848 by 848 pixels
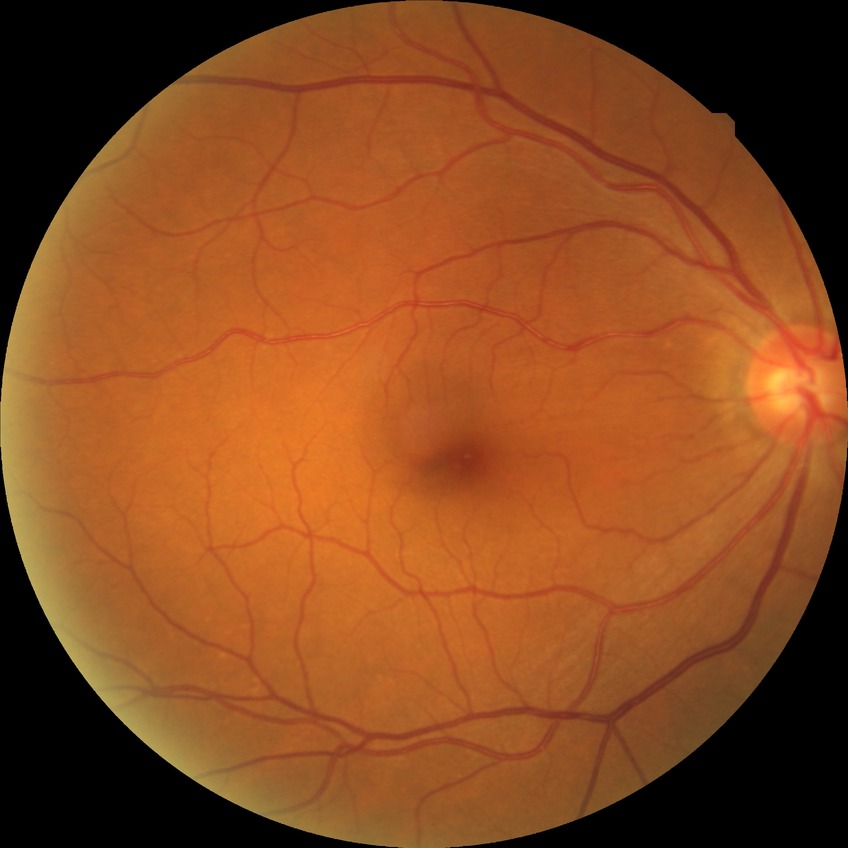
Modified Davis grading is no diabetic retinopathy.